Wide-field fundus image from infant ROP screening: 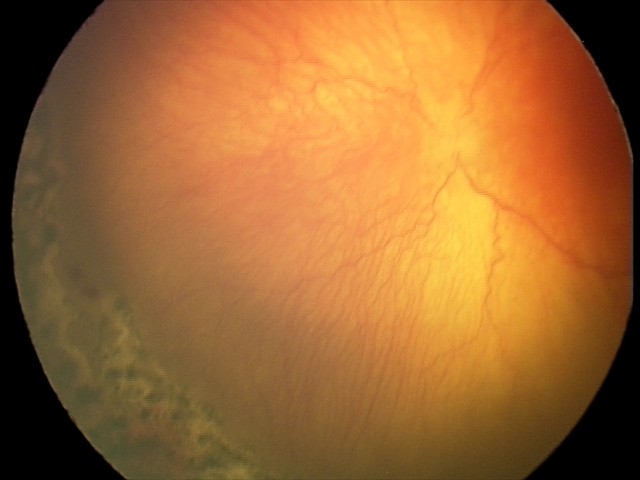

Screening diagnosis: aggressive retinopathy of prematurity (A-ROP); plus disease.